Color fundus image · 45° field of view · 848 x 848 pixels · NIDEK AFC-230:
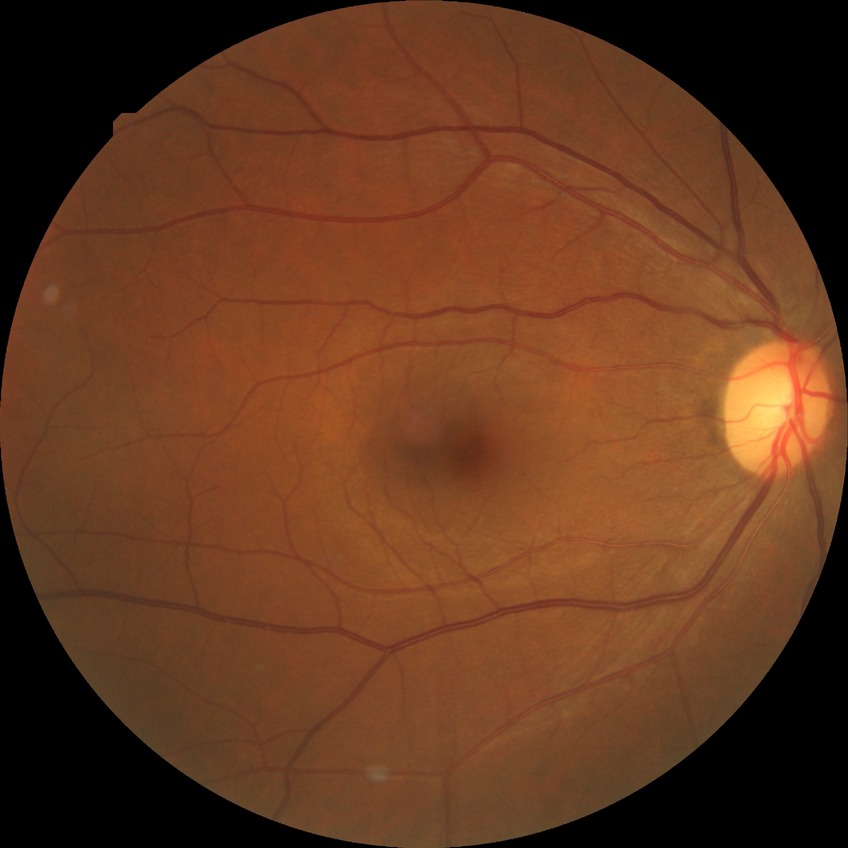 Diabetic retinopathy (DR) is no diabetic retinopathy (NDR).